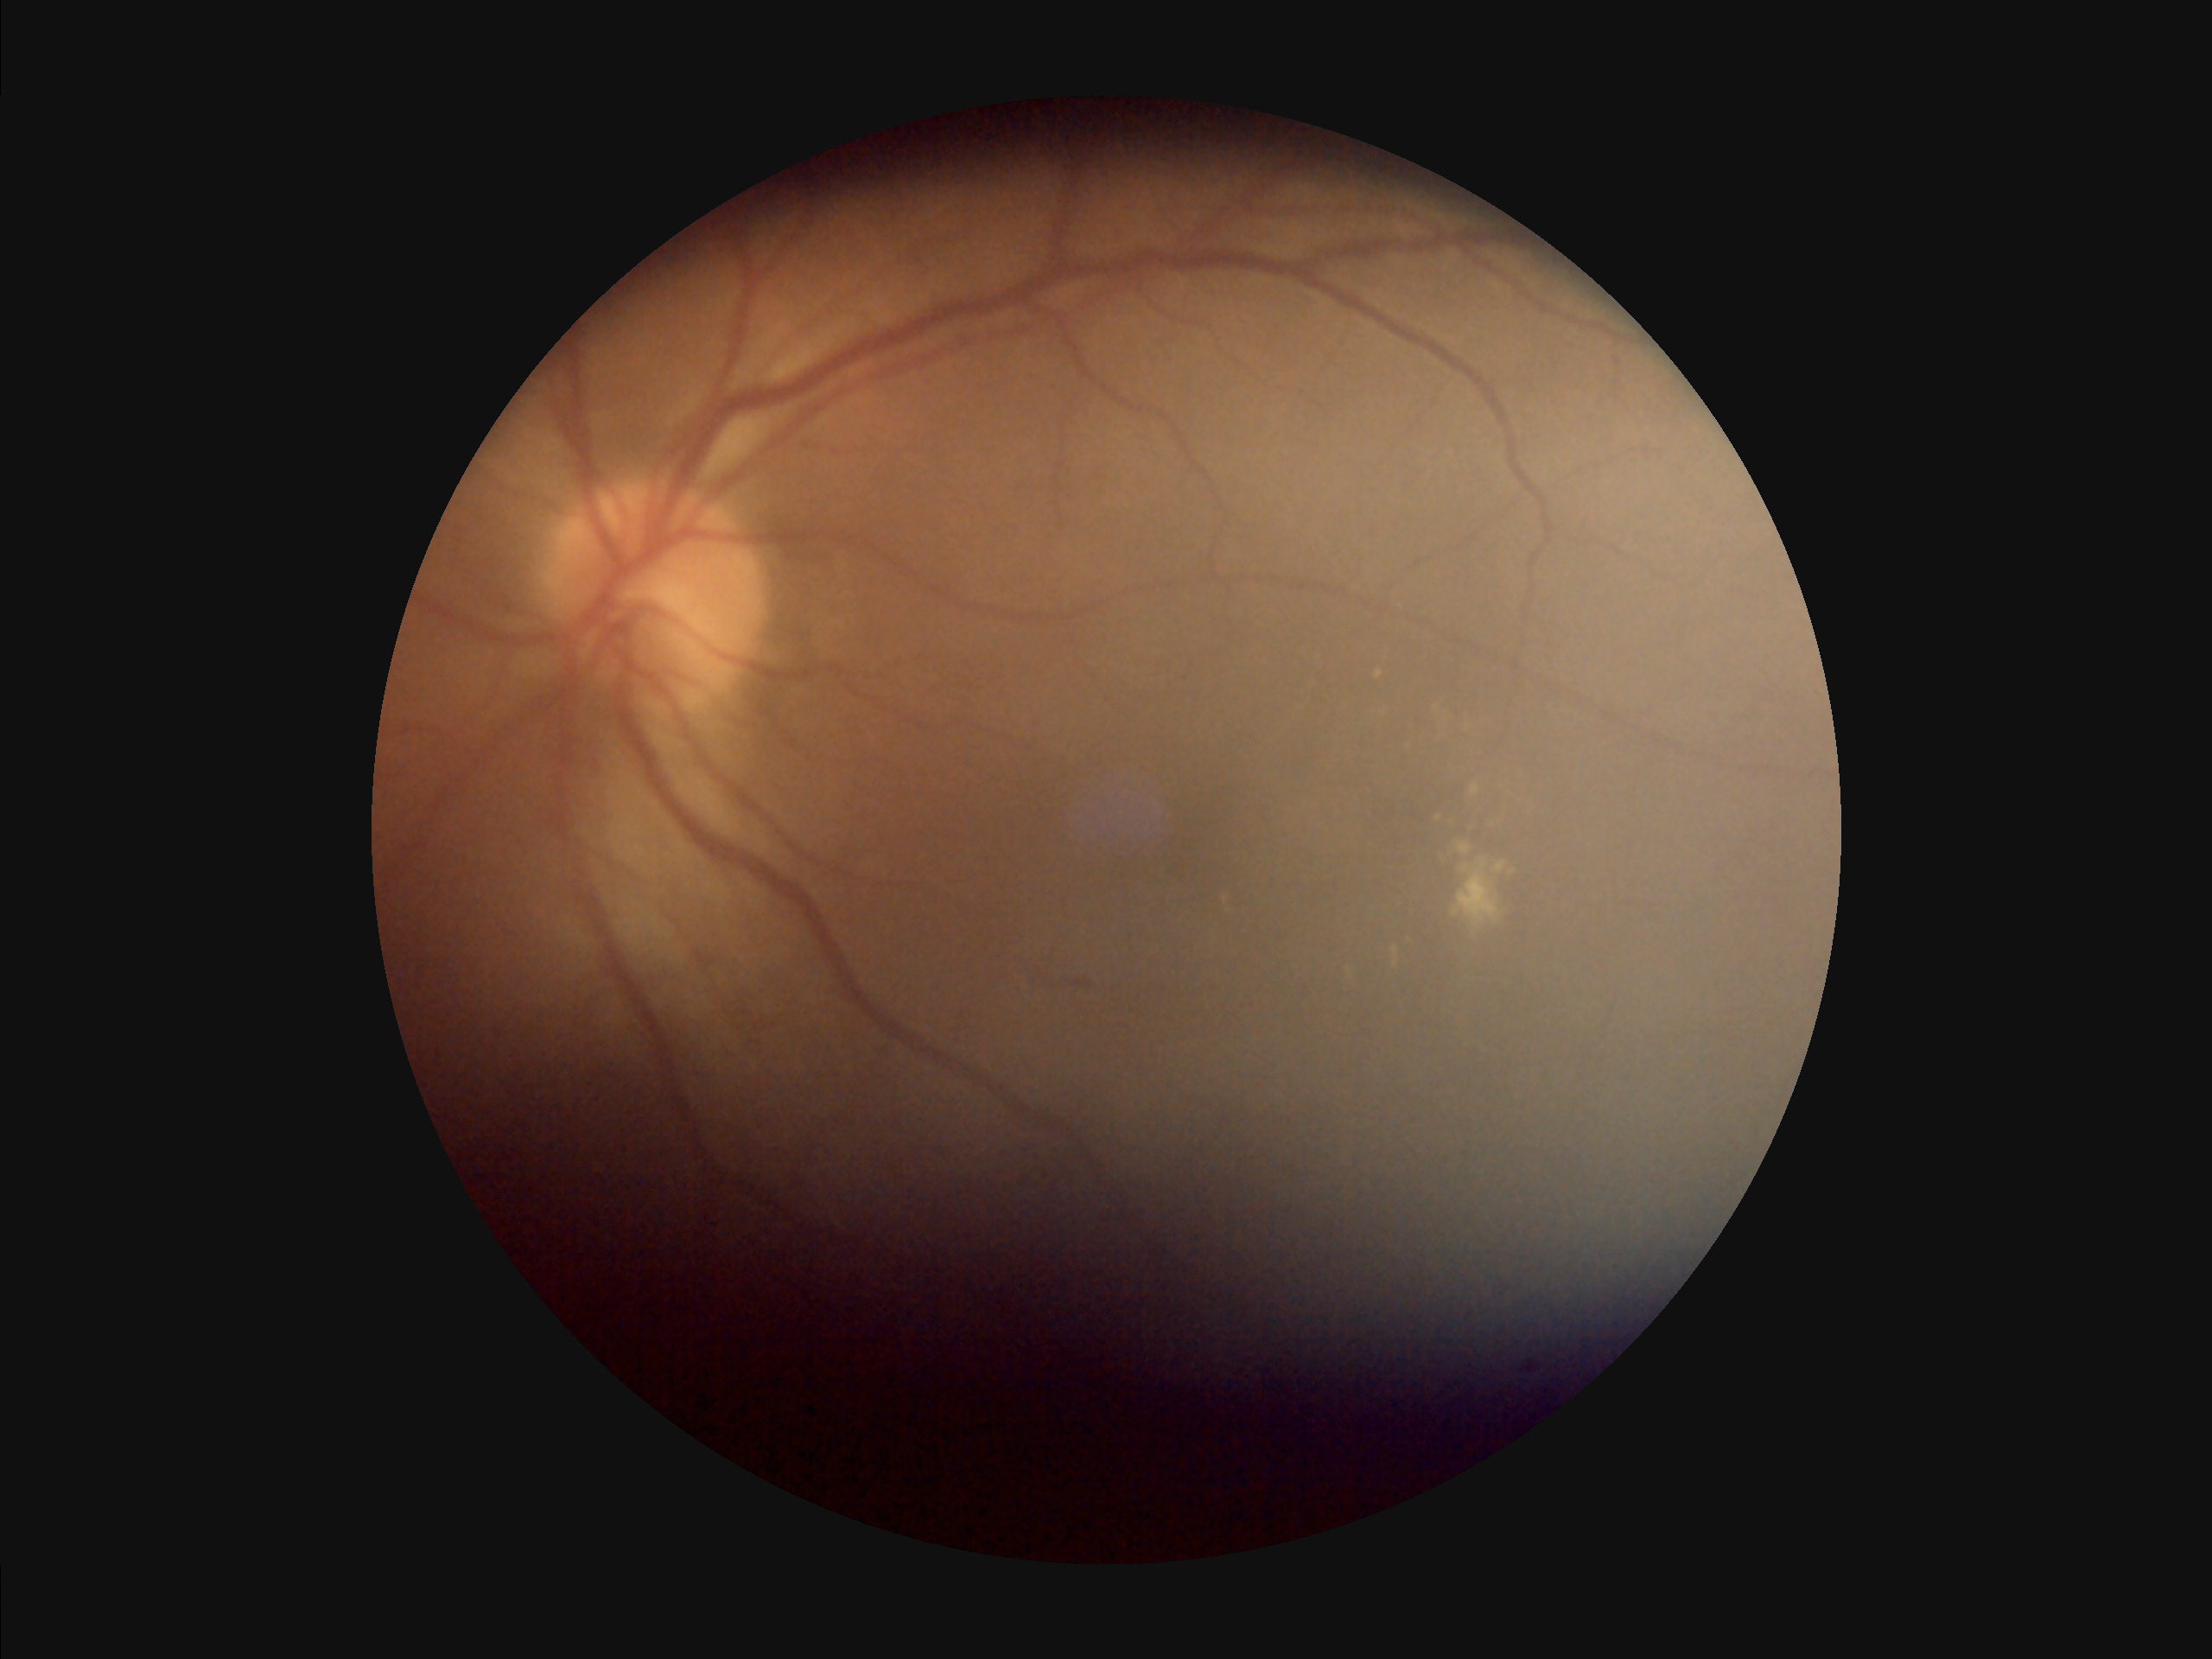
Reduced sharpness with visible blur. Poor illumination with uneven exposure. Image quality is inadequate for diagnostic use.